Wide-field fundus photograph of an infant — 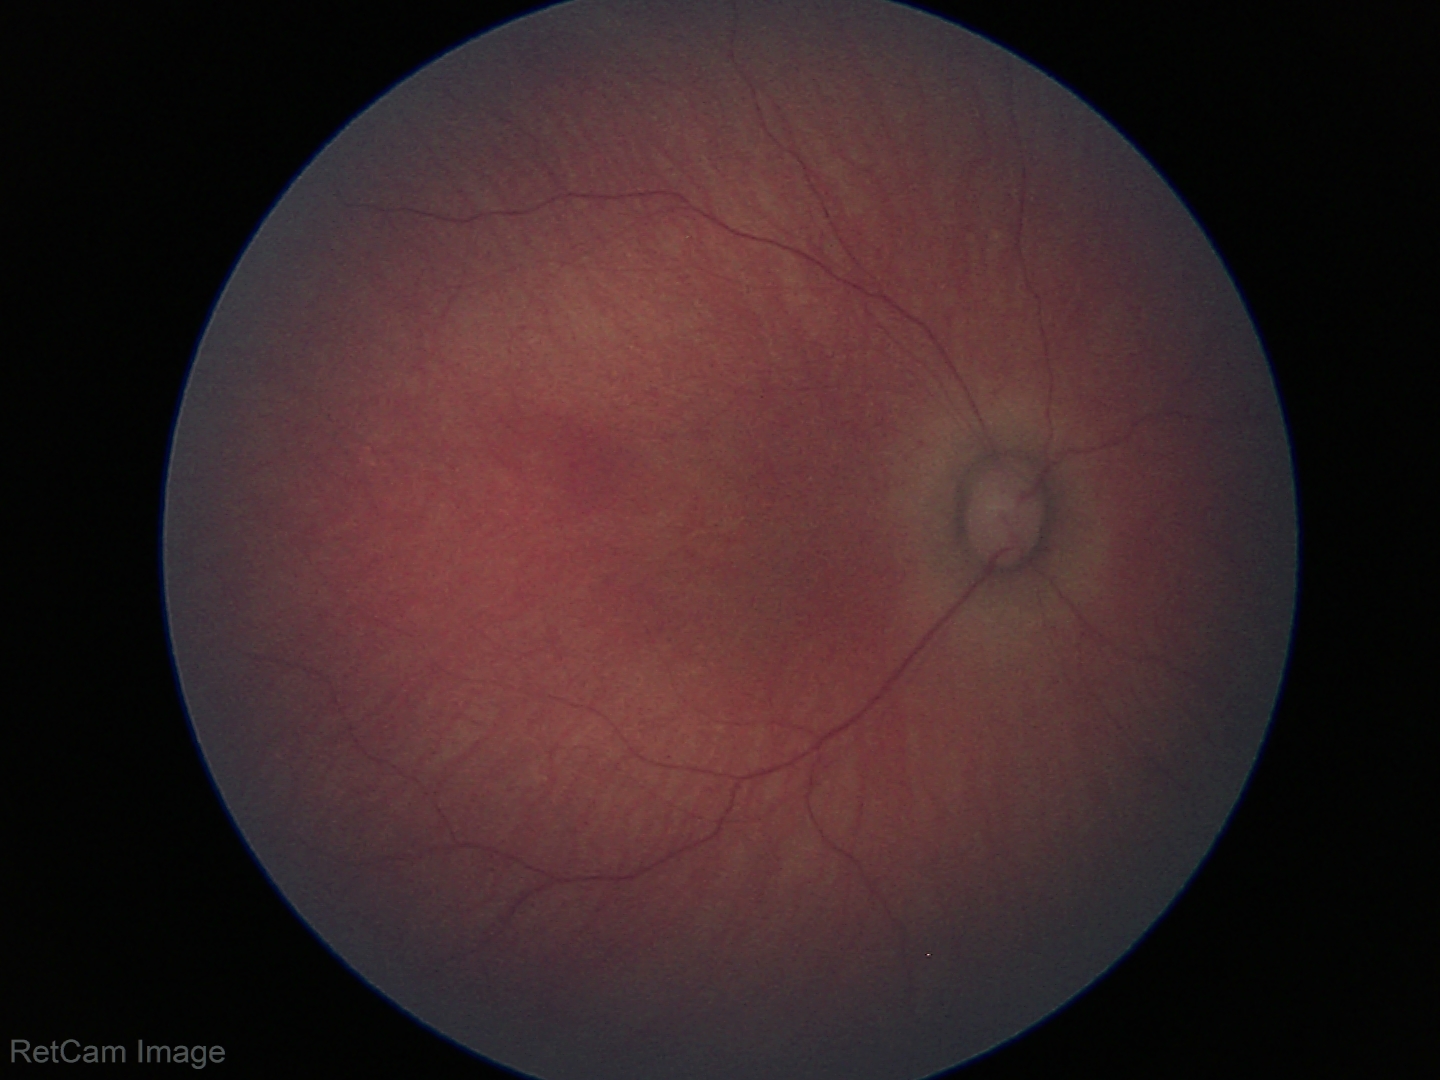

Normal screening examination.